FOV: 45 degrees
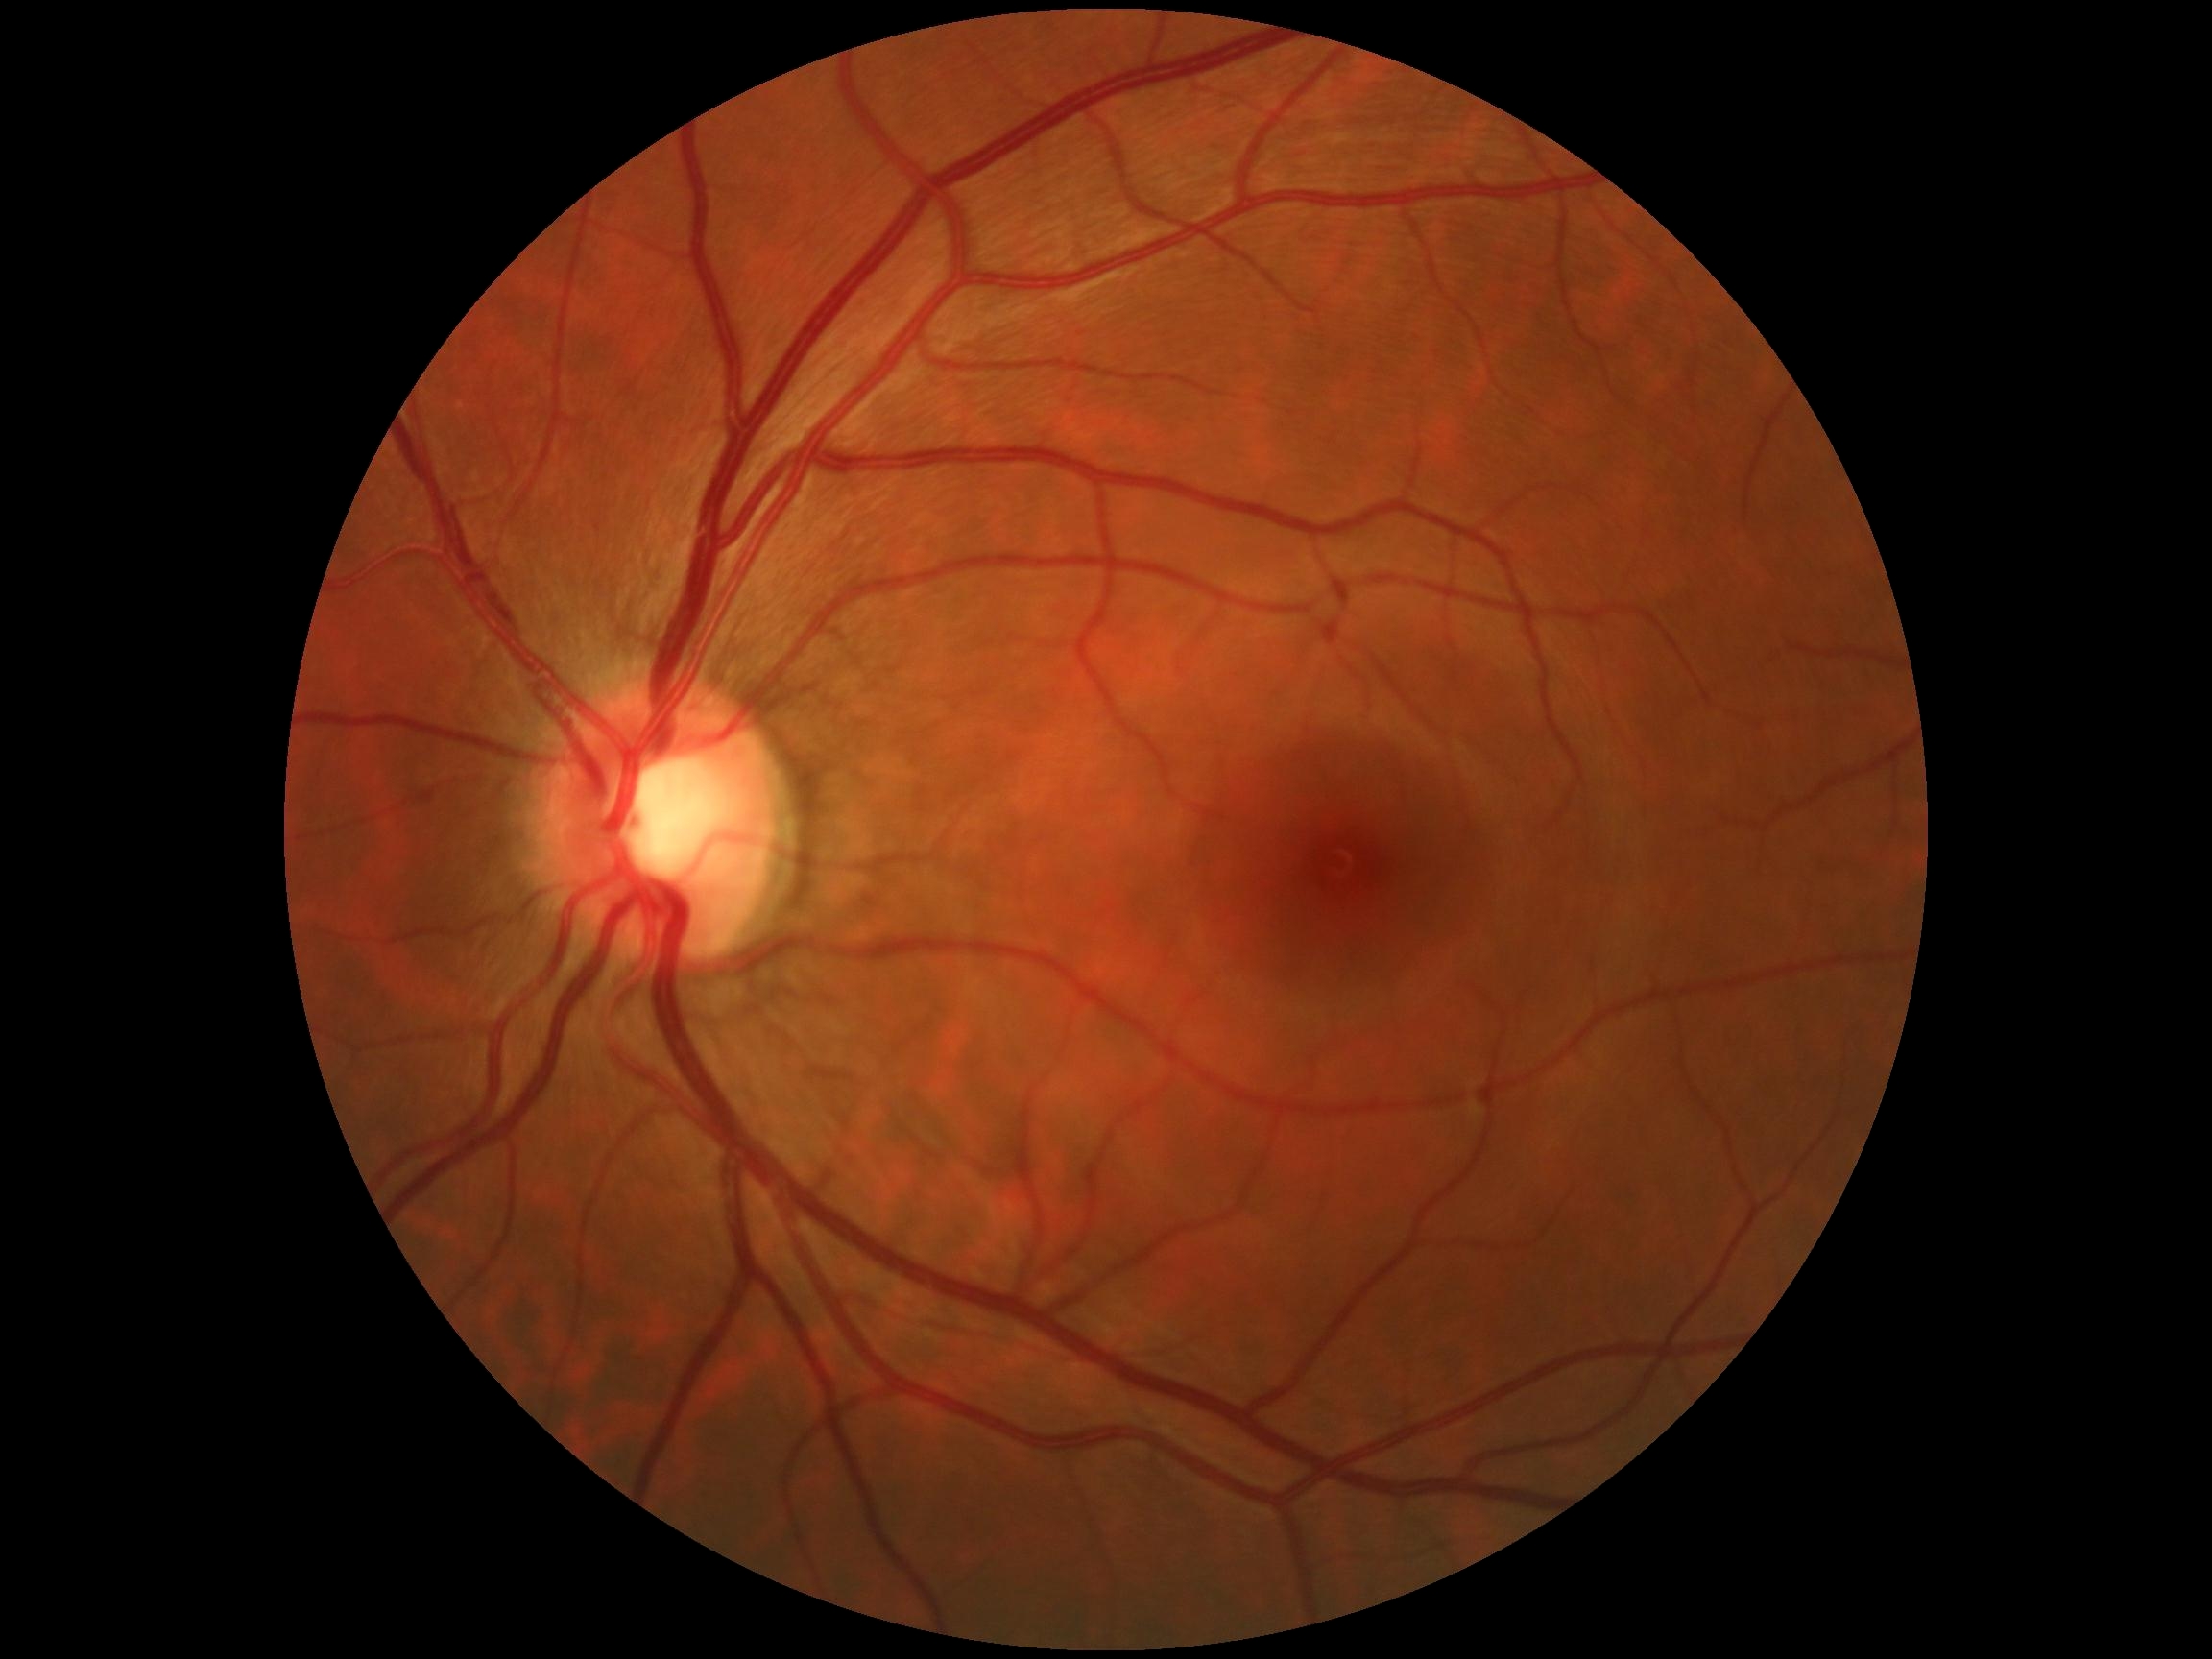

DR: no apparent diabetic retinopathy (grade 0).